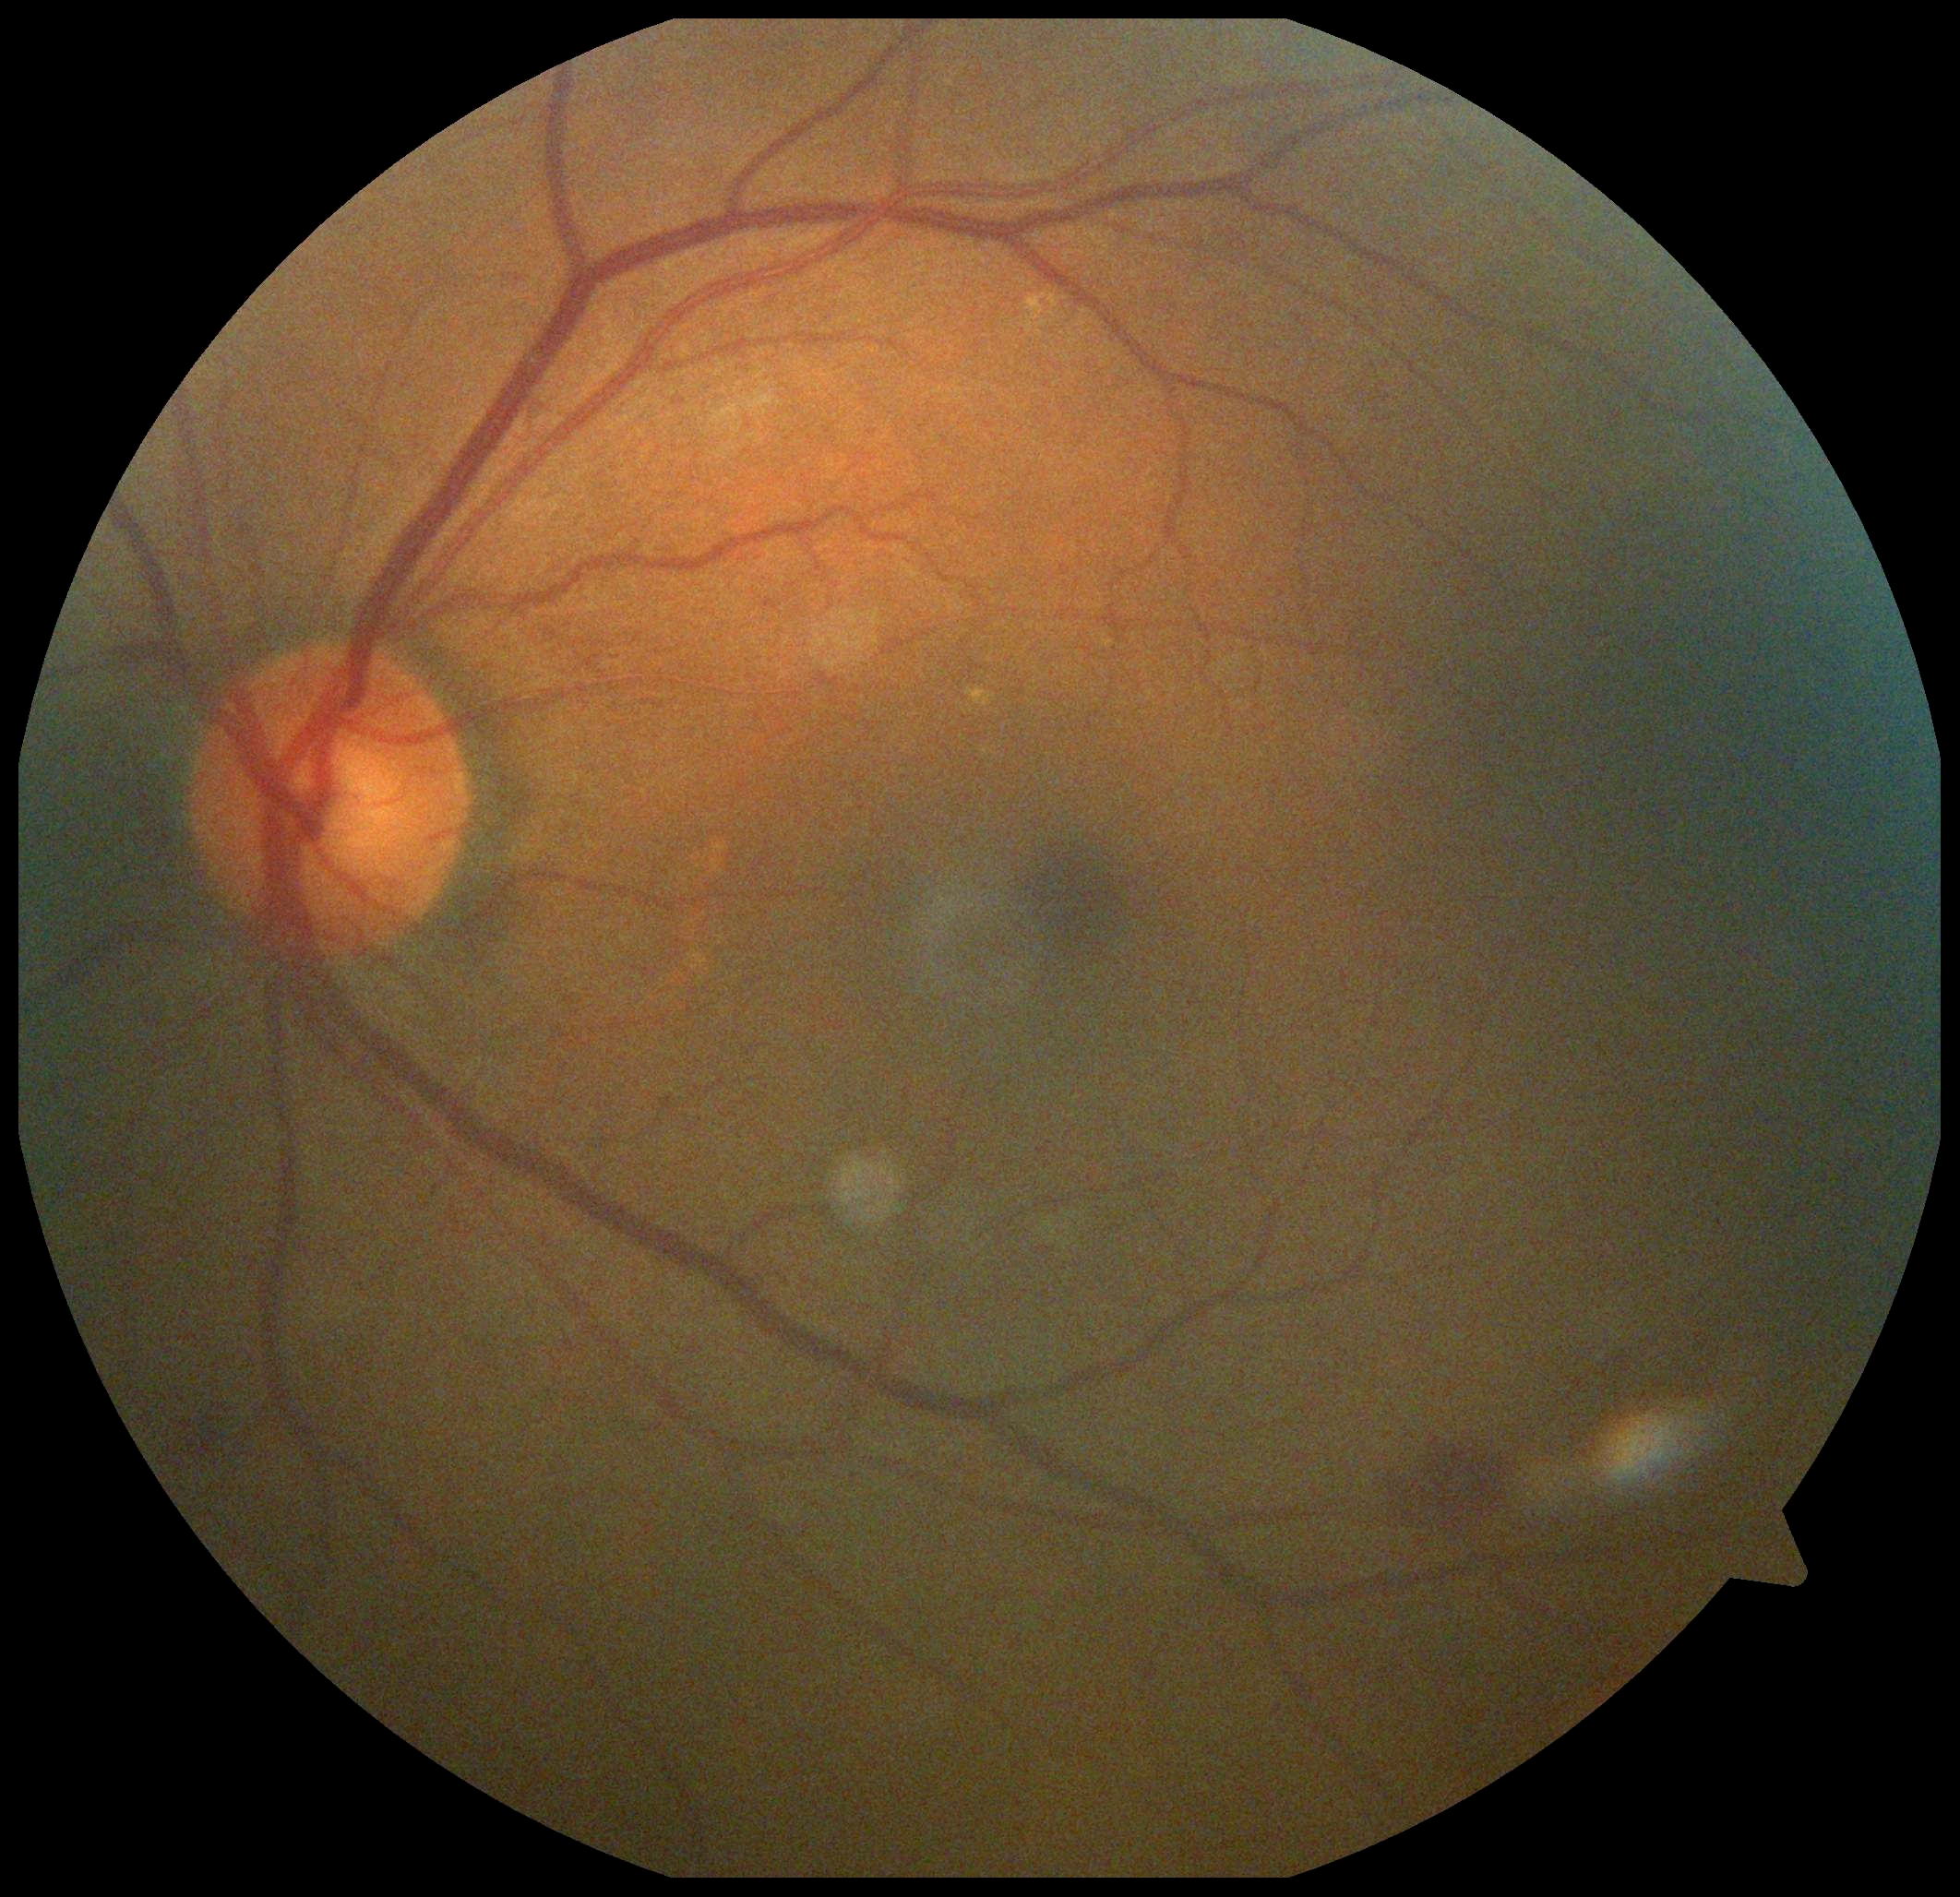
DR grade@2 (moderate NPDR); DR class@non-proliferative diabetic retinopathy.